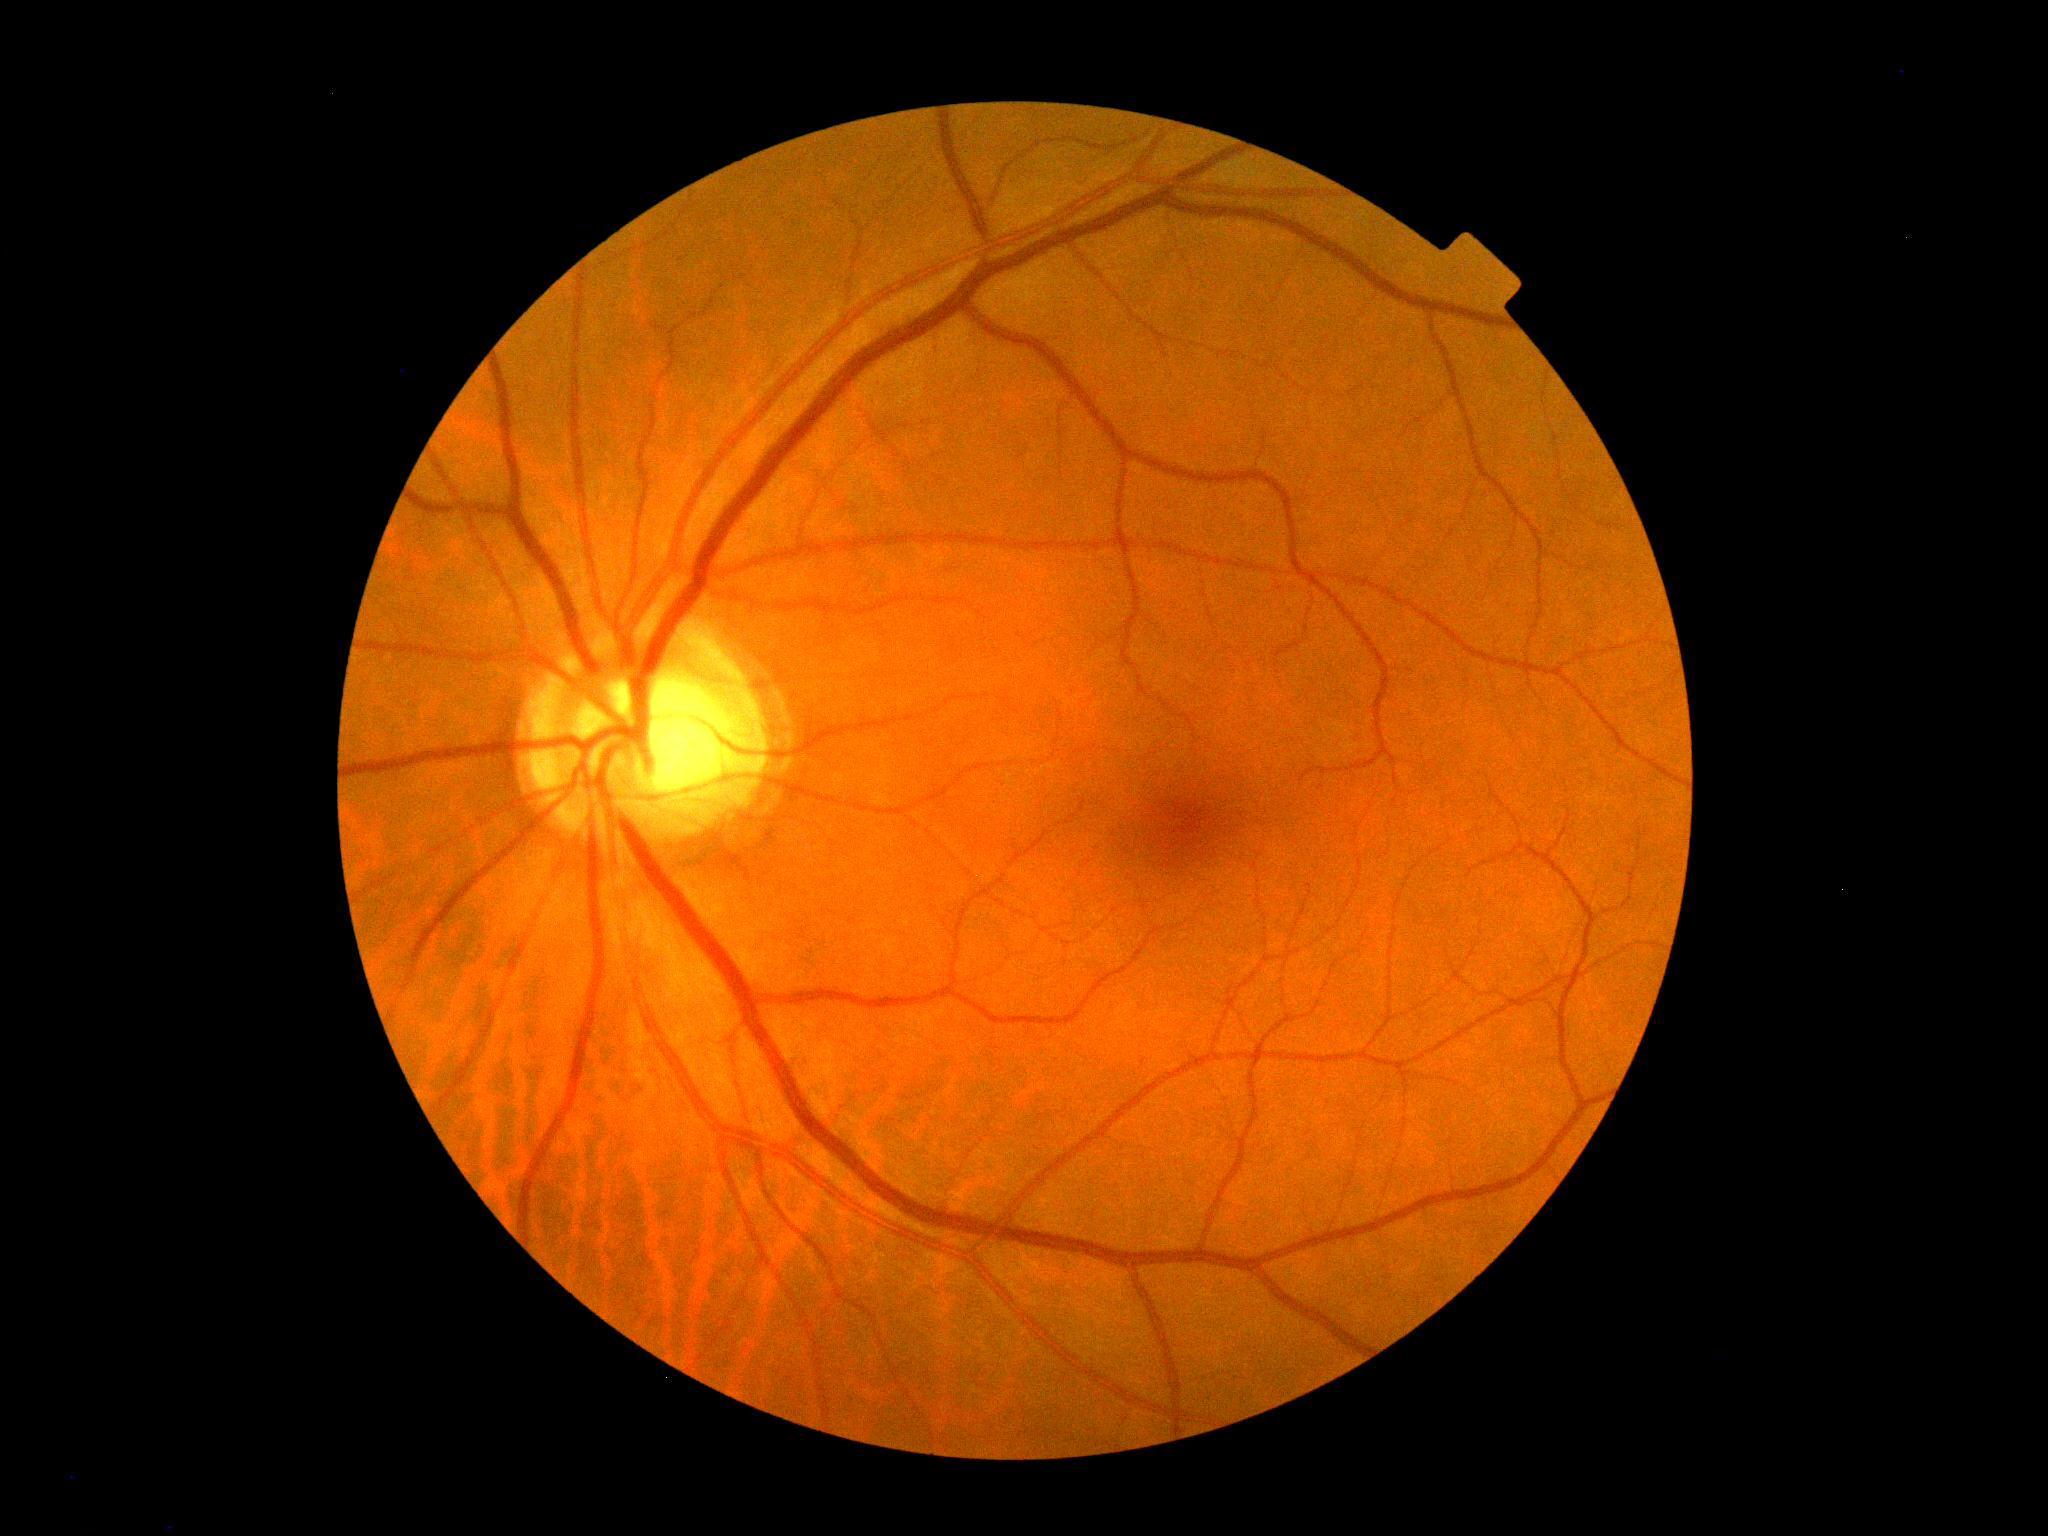
Diabetic retinopathy is grade 0.